Color fundus image
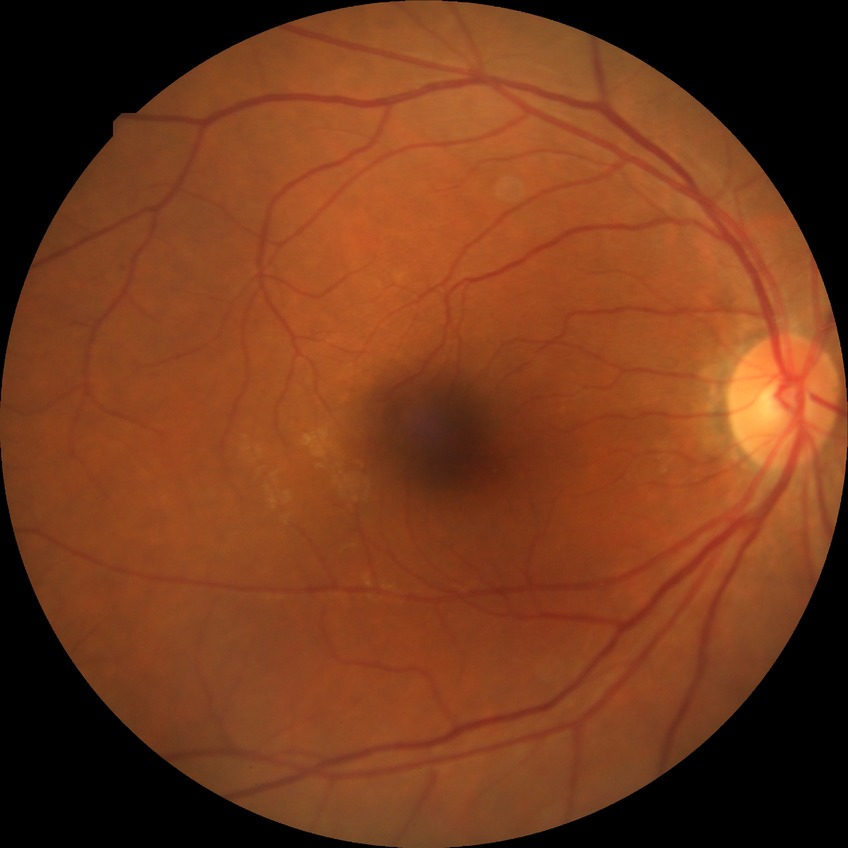

Diabetic retinopathy (DR) is no diabetic retinopathy (NDR).